45-degree field of view · CFP: 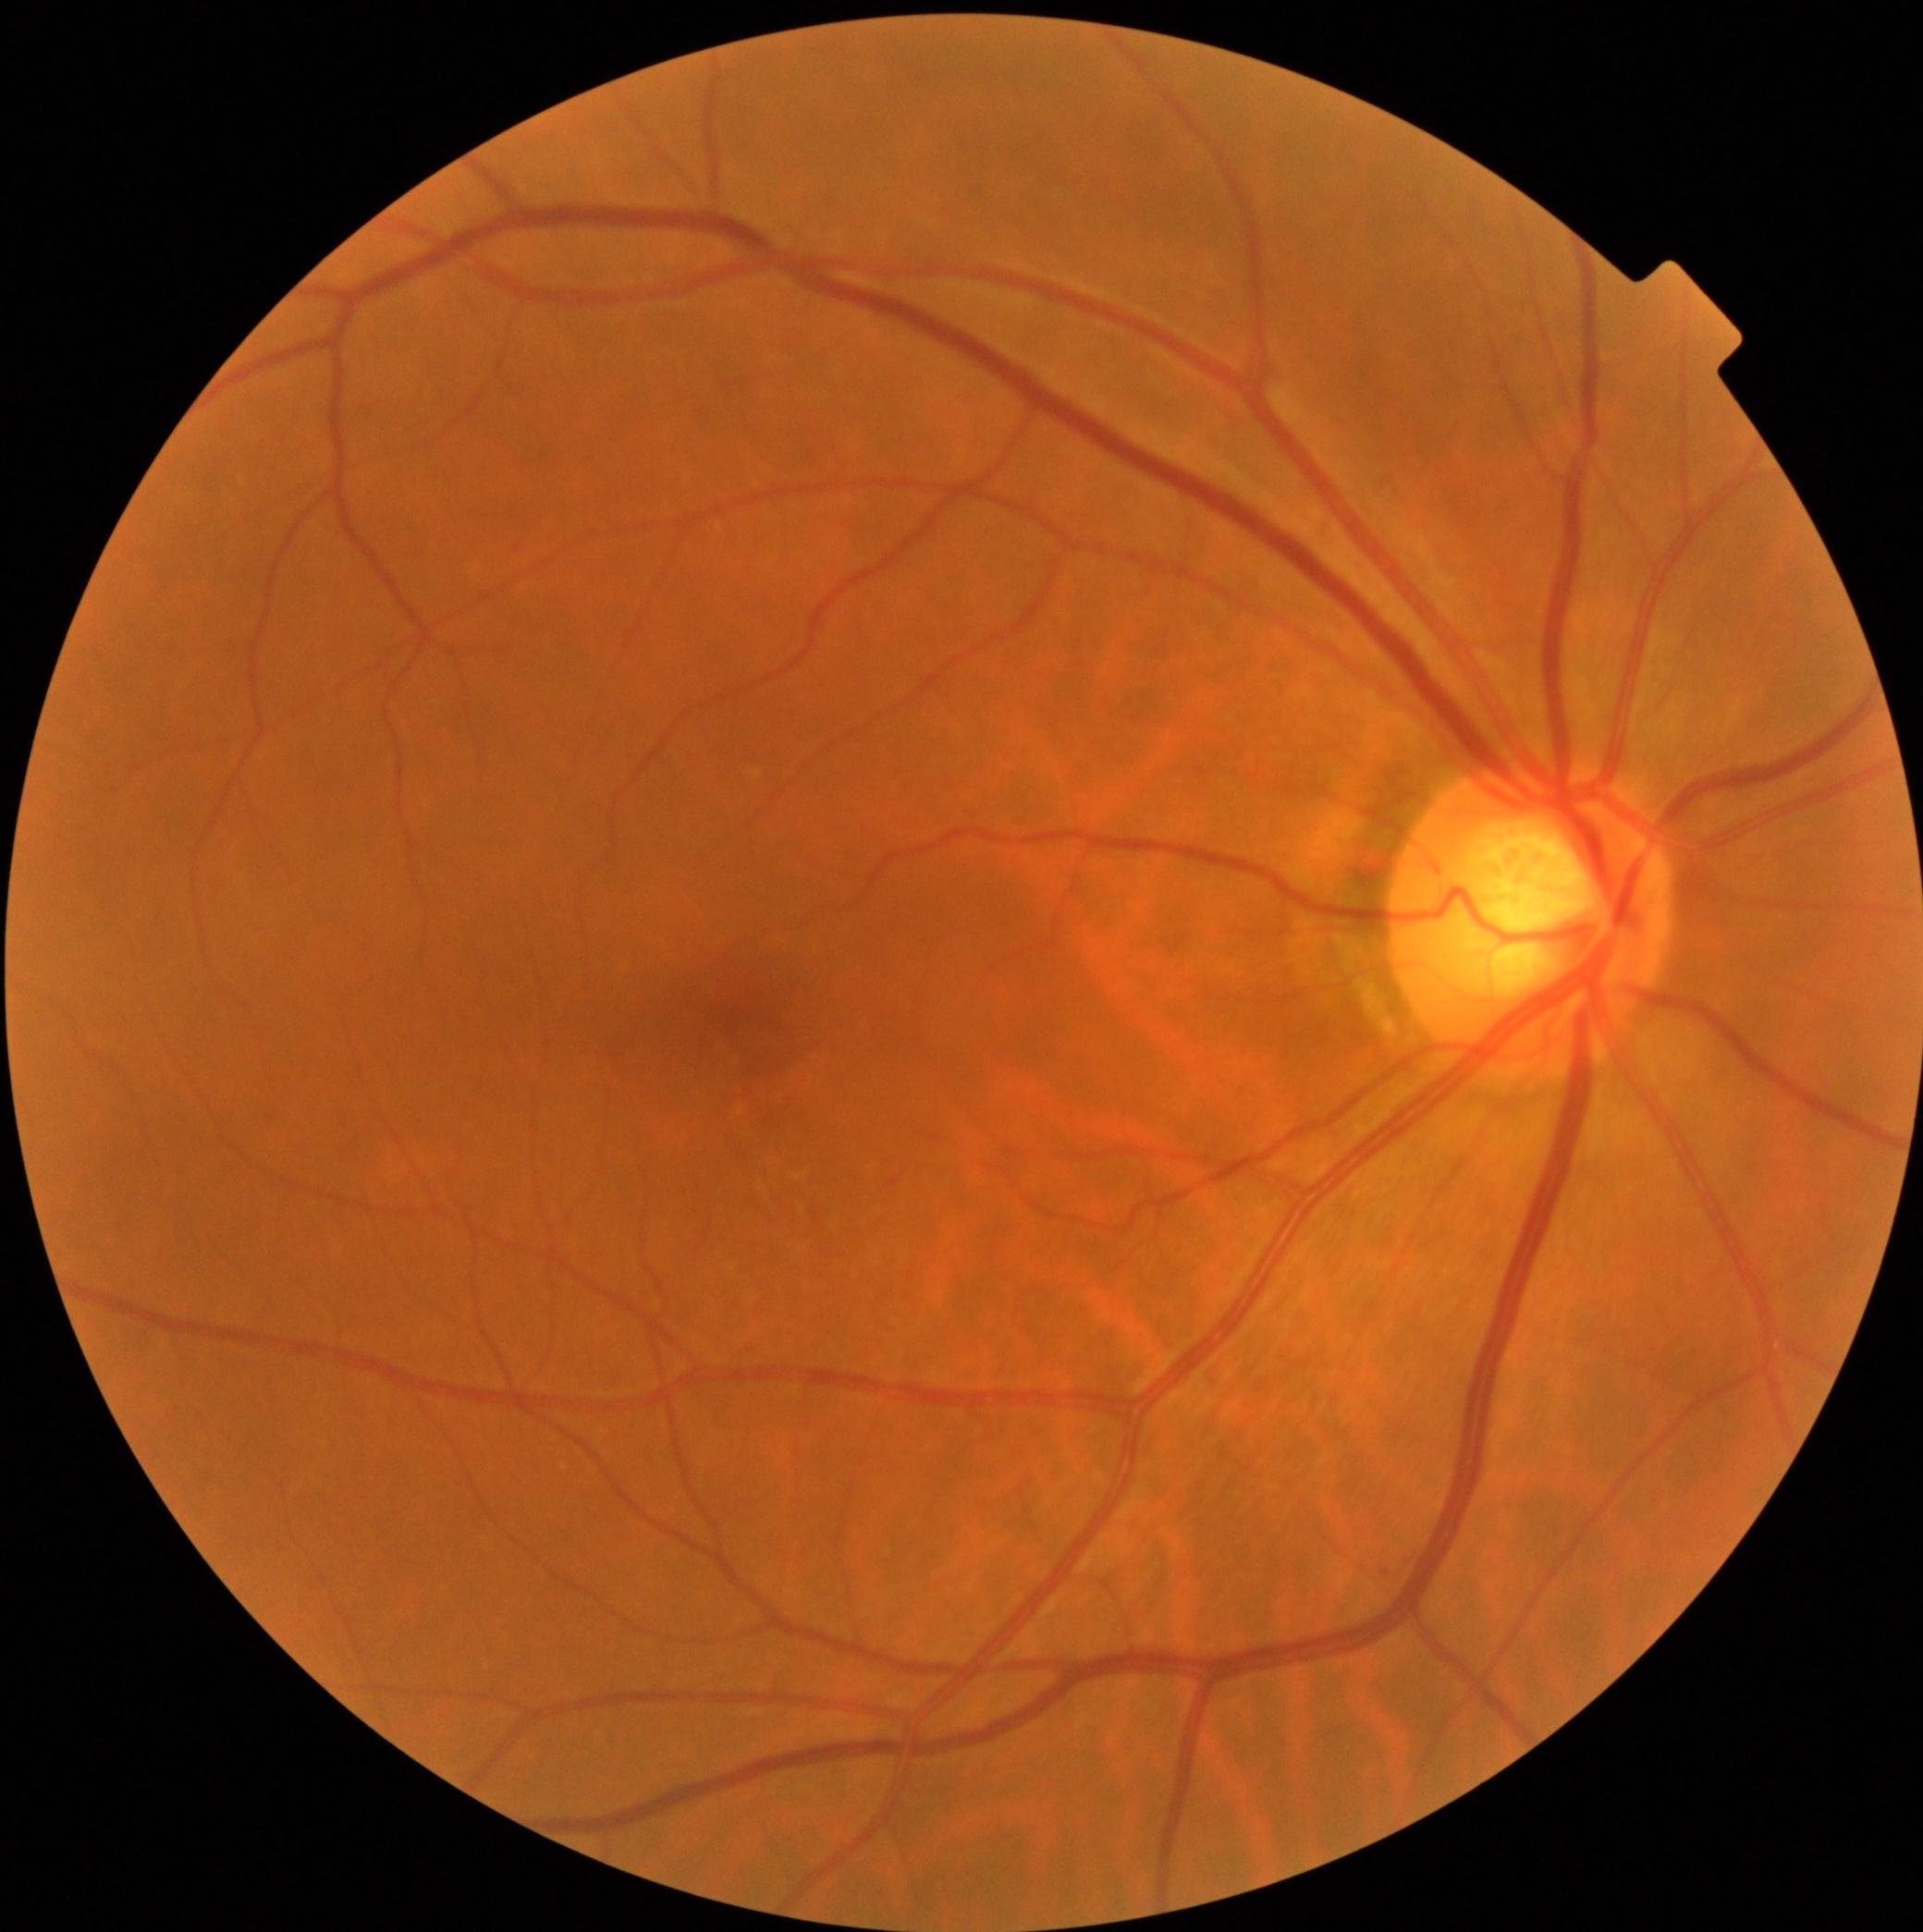
retinopathy = grade 1 (mild NPDR).